848x848; FOV: 45 degrees; posterior pole photograph; without pupil dilation; camera: NIDEK AFC-230 — 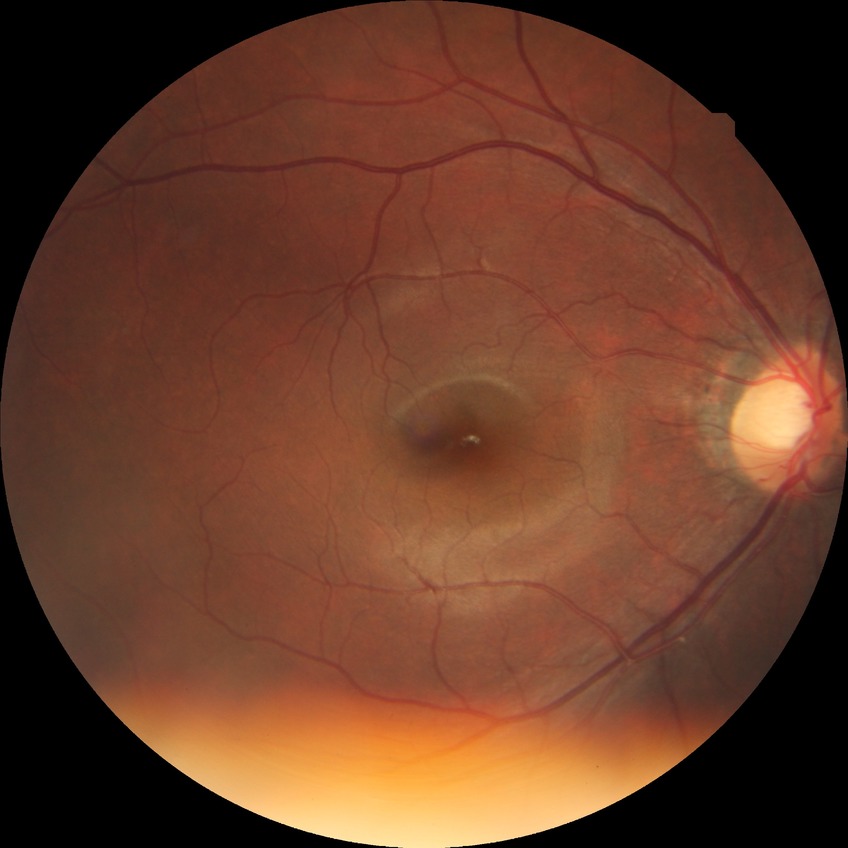

Diabetic retinopathy (DR) is NDR (no diabetic retinopathy).